45° FOV.
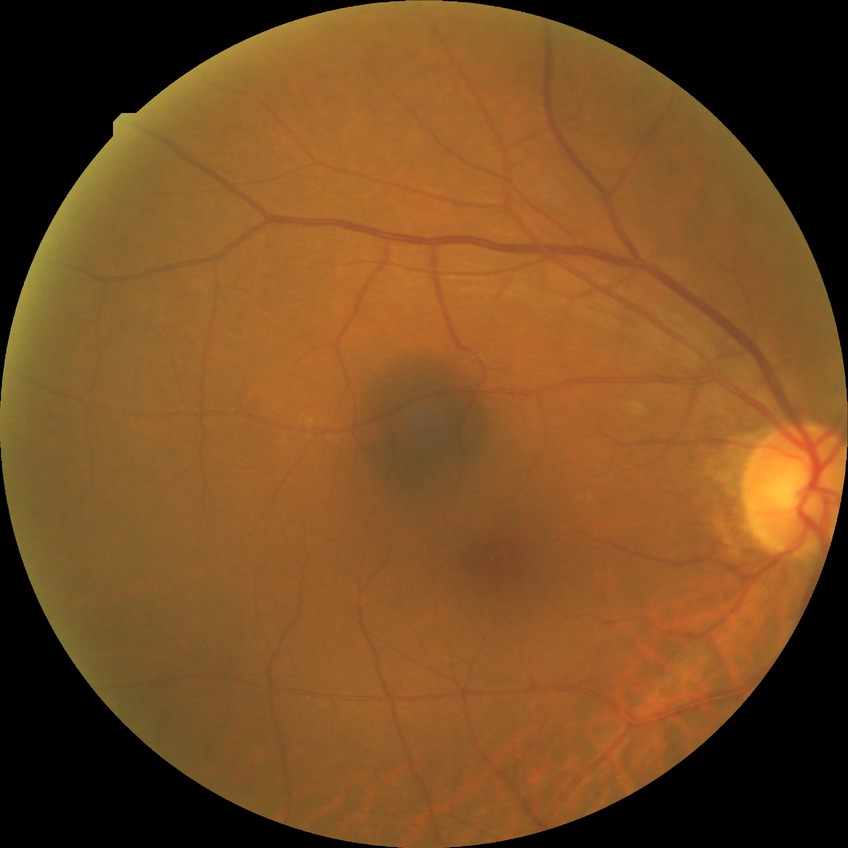 modified Davis grade = NDR
DR impression = no apparent DR